Image size 2212x1659 — 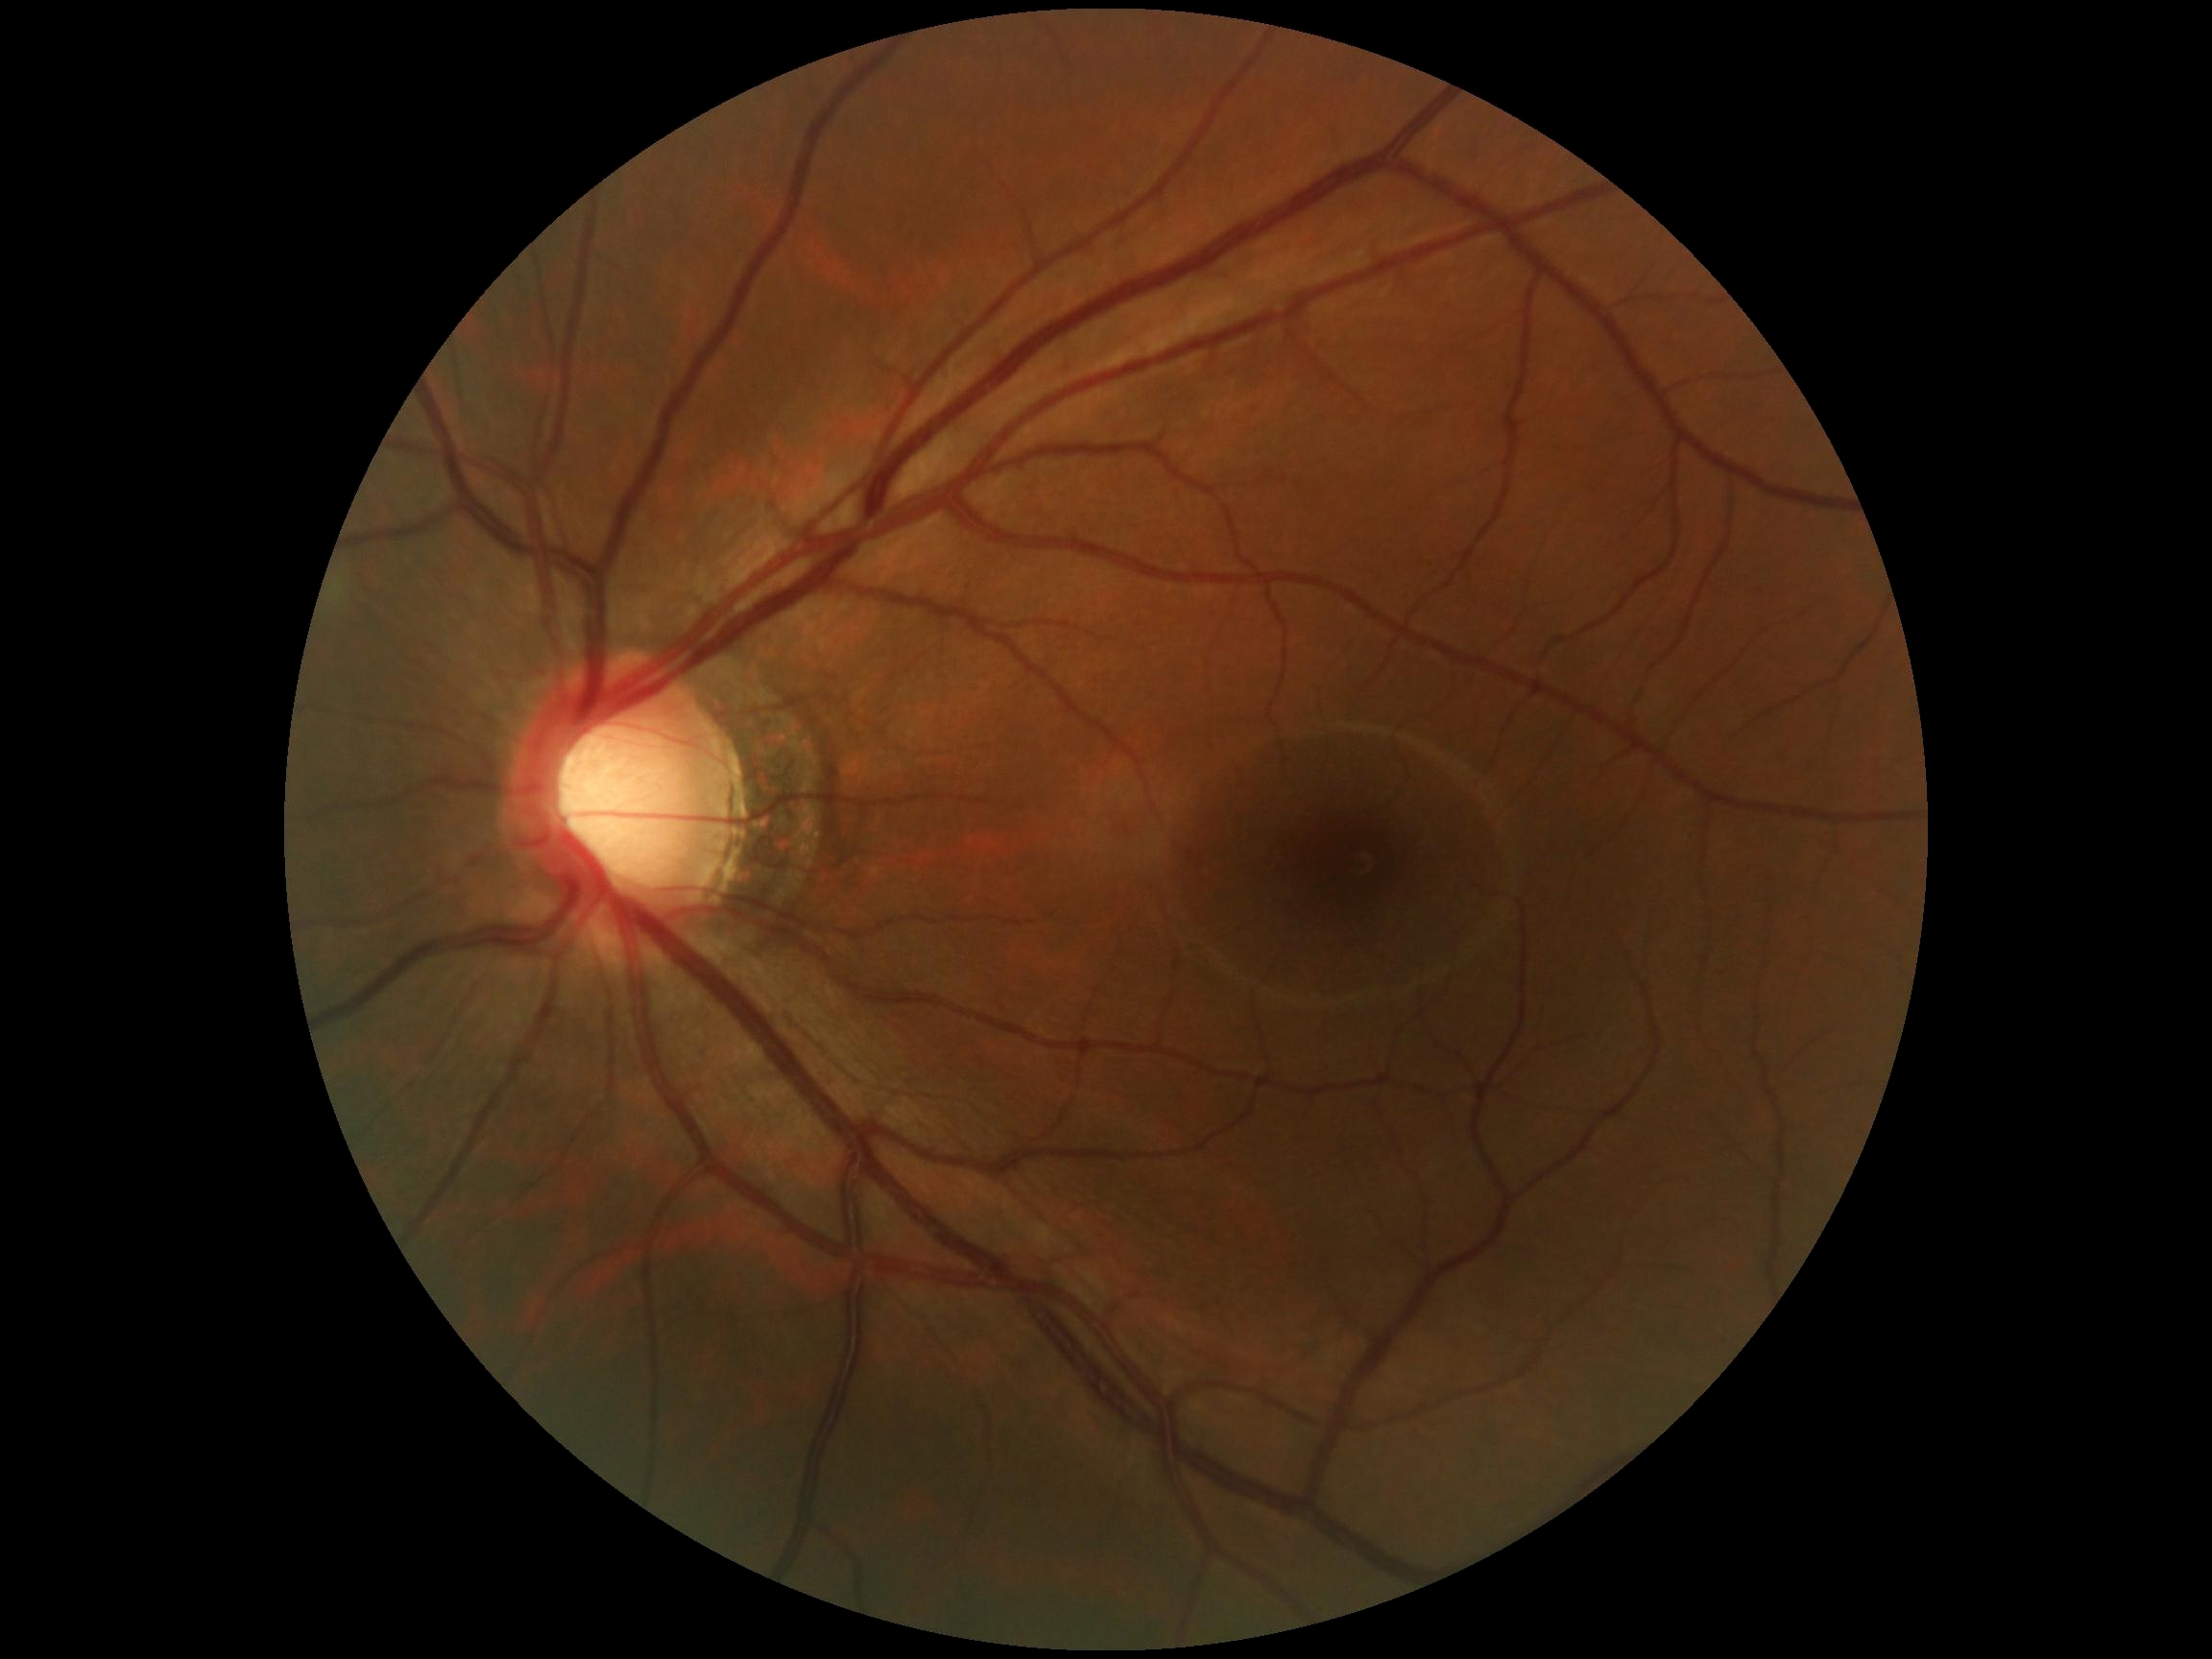 DR impression = no DR findings | diabetic retinopathy (DR) = grade 0 (no apparent retinopathy).